2352x1568 · fundus photo: 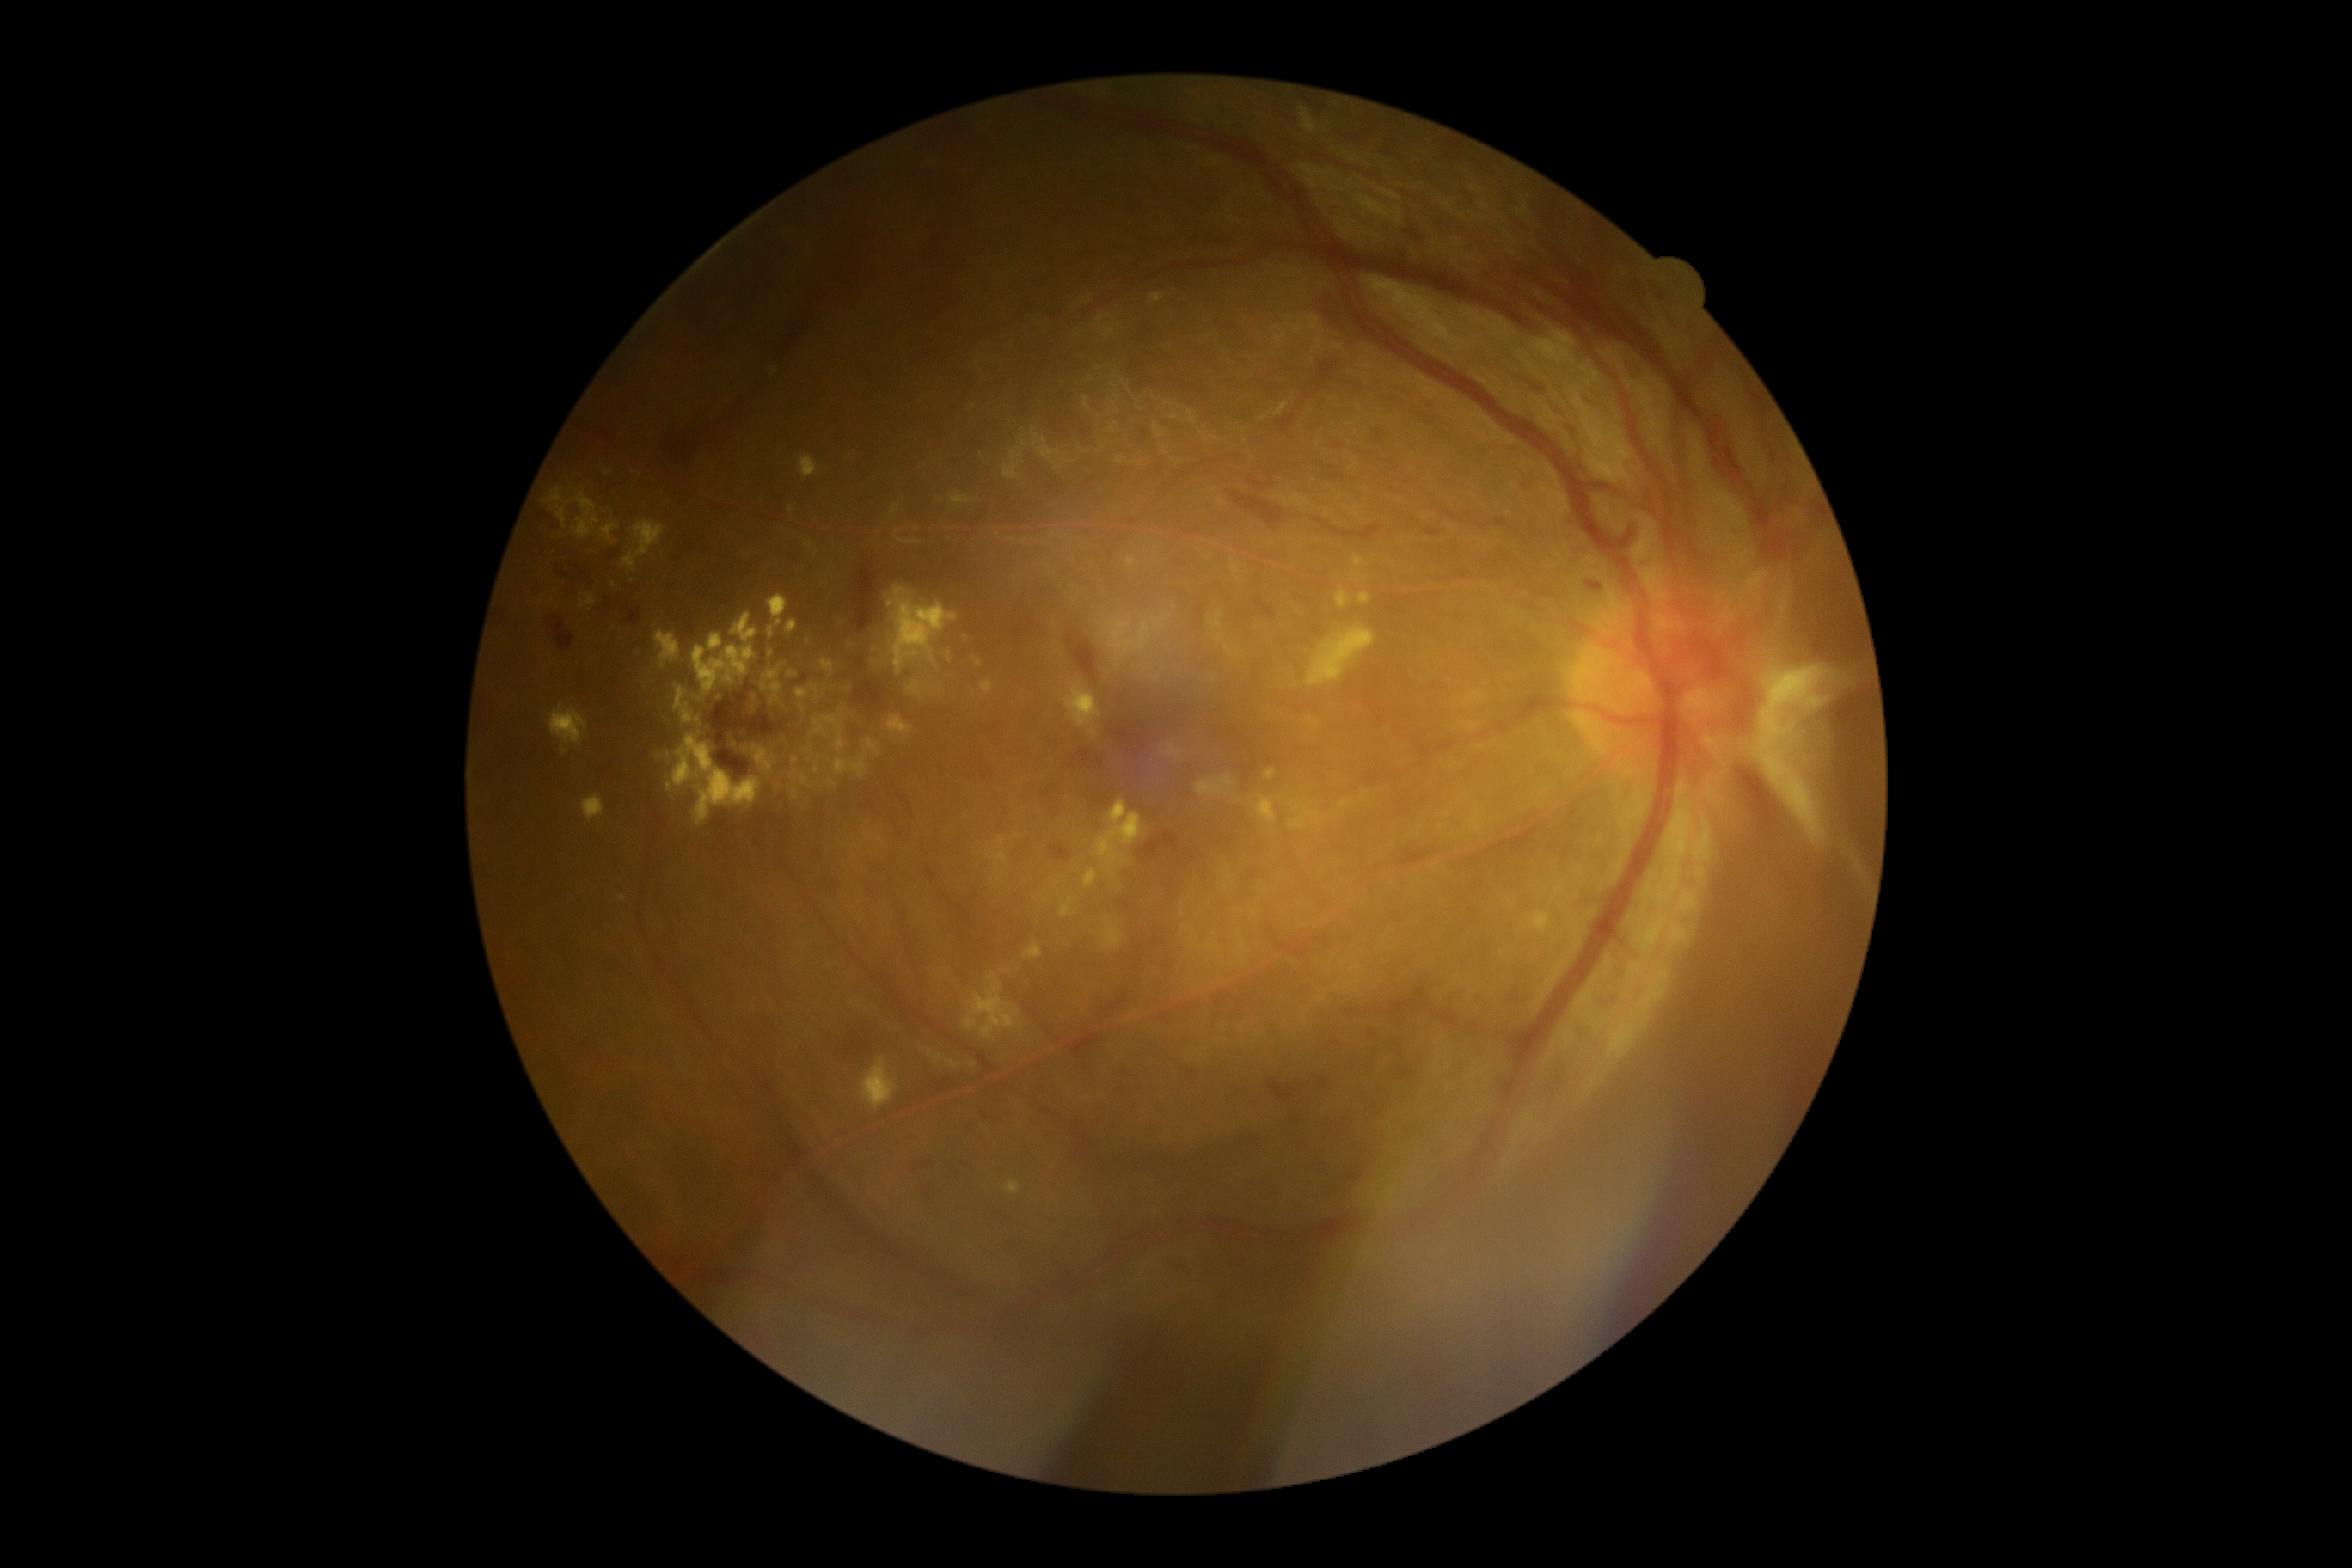 Diabetic retinopathy (DR) is PDR (grade 4).
Hard exudates (EXs) include those at 787,620,797,634 | 1077,694,1098,714 | 788,671,797,677 | 673,735,759,824 | 792,790,797,800 | 709,634,725,651 | 1524,912,1552,934 | 836,732,847,754 | 659,749,673,763 | 1266,769,1277,780 | 811,683,819,694 | 623,522,666,573 | 656,632,680,668 | 601,524,618,542 | 885,716,914,738.
Small EXs approximately at [809, 642] | [802, 709] | [698, 720].
No microaneurysms (MAs) identified.
No soft exudates (SEs) identified.
Hemorrhages (HEs) include those at 601,594,615,627 | 1332,1041,1340,1048 | 1099,991,1130,1019 | 1325,474,1345,481 | 665,202,847,462 | 1588,582,1603,591 | 1266,1079,1294,1101 | 609,551,620,561 | 1050,845,1072,862 | 761,647,766,666 | 914,1158,931,1168 | 924,867,940,883 | 964,1120,981,1137 | 556,563,592,596 | 1423,527,1442,537 | 1232,494,1287,532.
Small HEs approximately at [1123, 1091].